Davis DR grading; acquired with a NIDEK AFC-230: 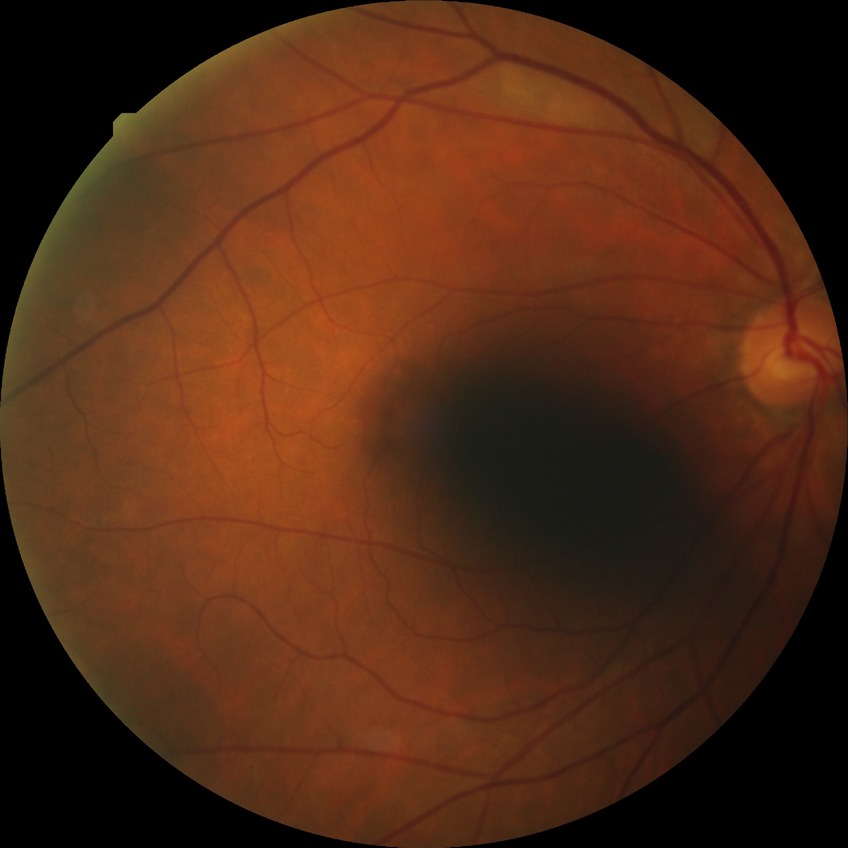 Diabetic retinopathy (DR): no diabetic retinopathy (NDR).